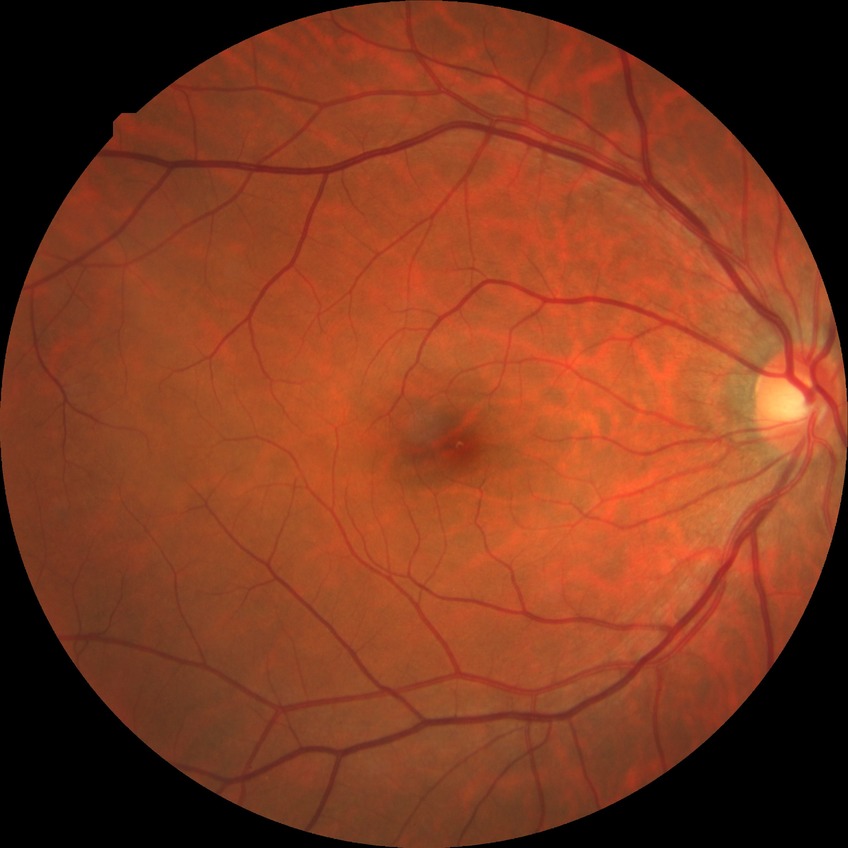
Diabetic retinopathy (DR): NDR (no diabetic retinopathy).